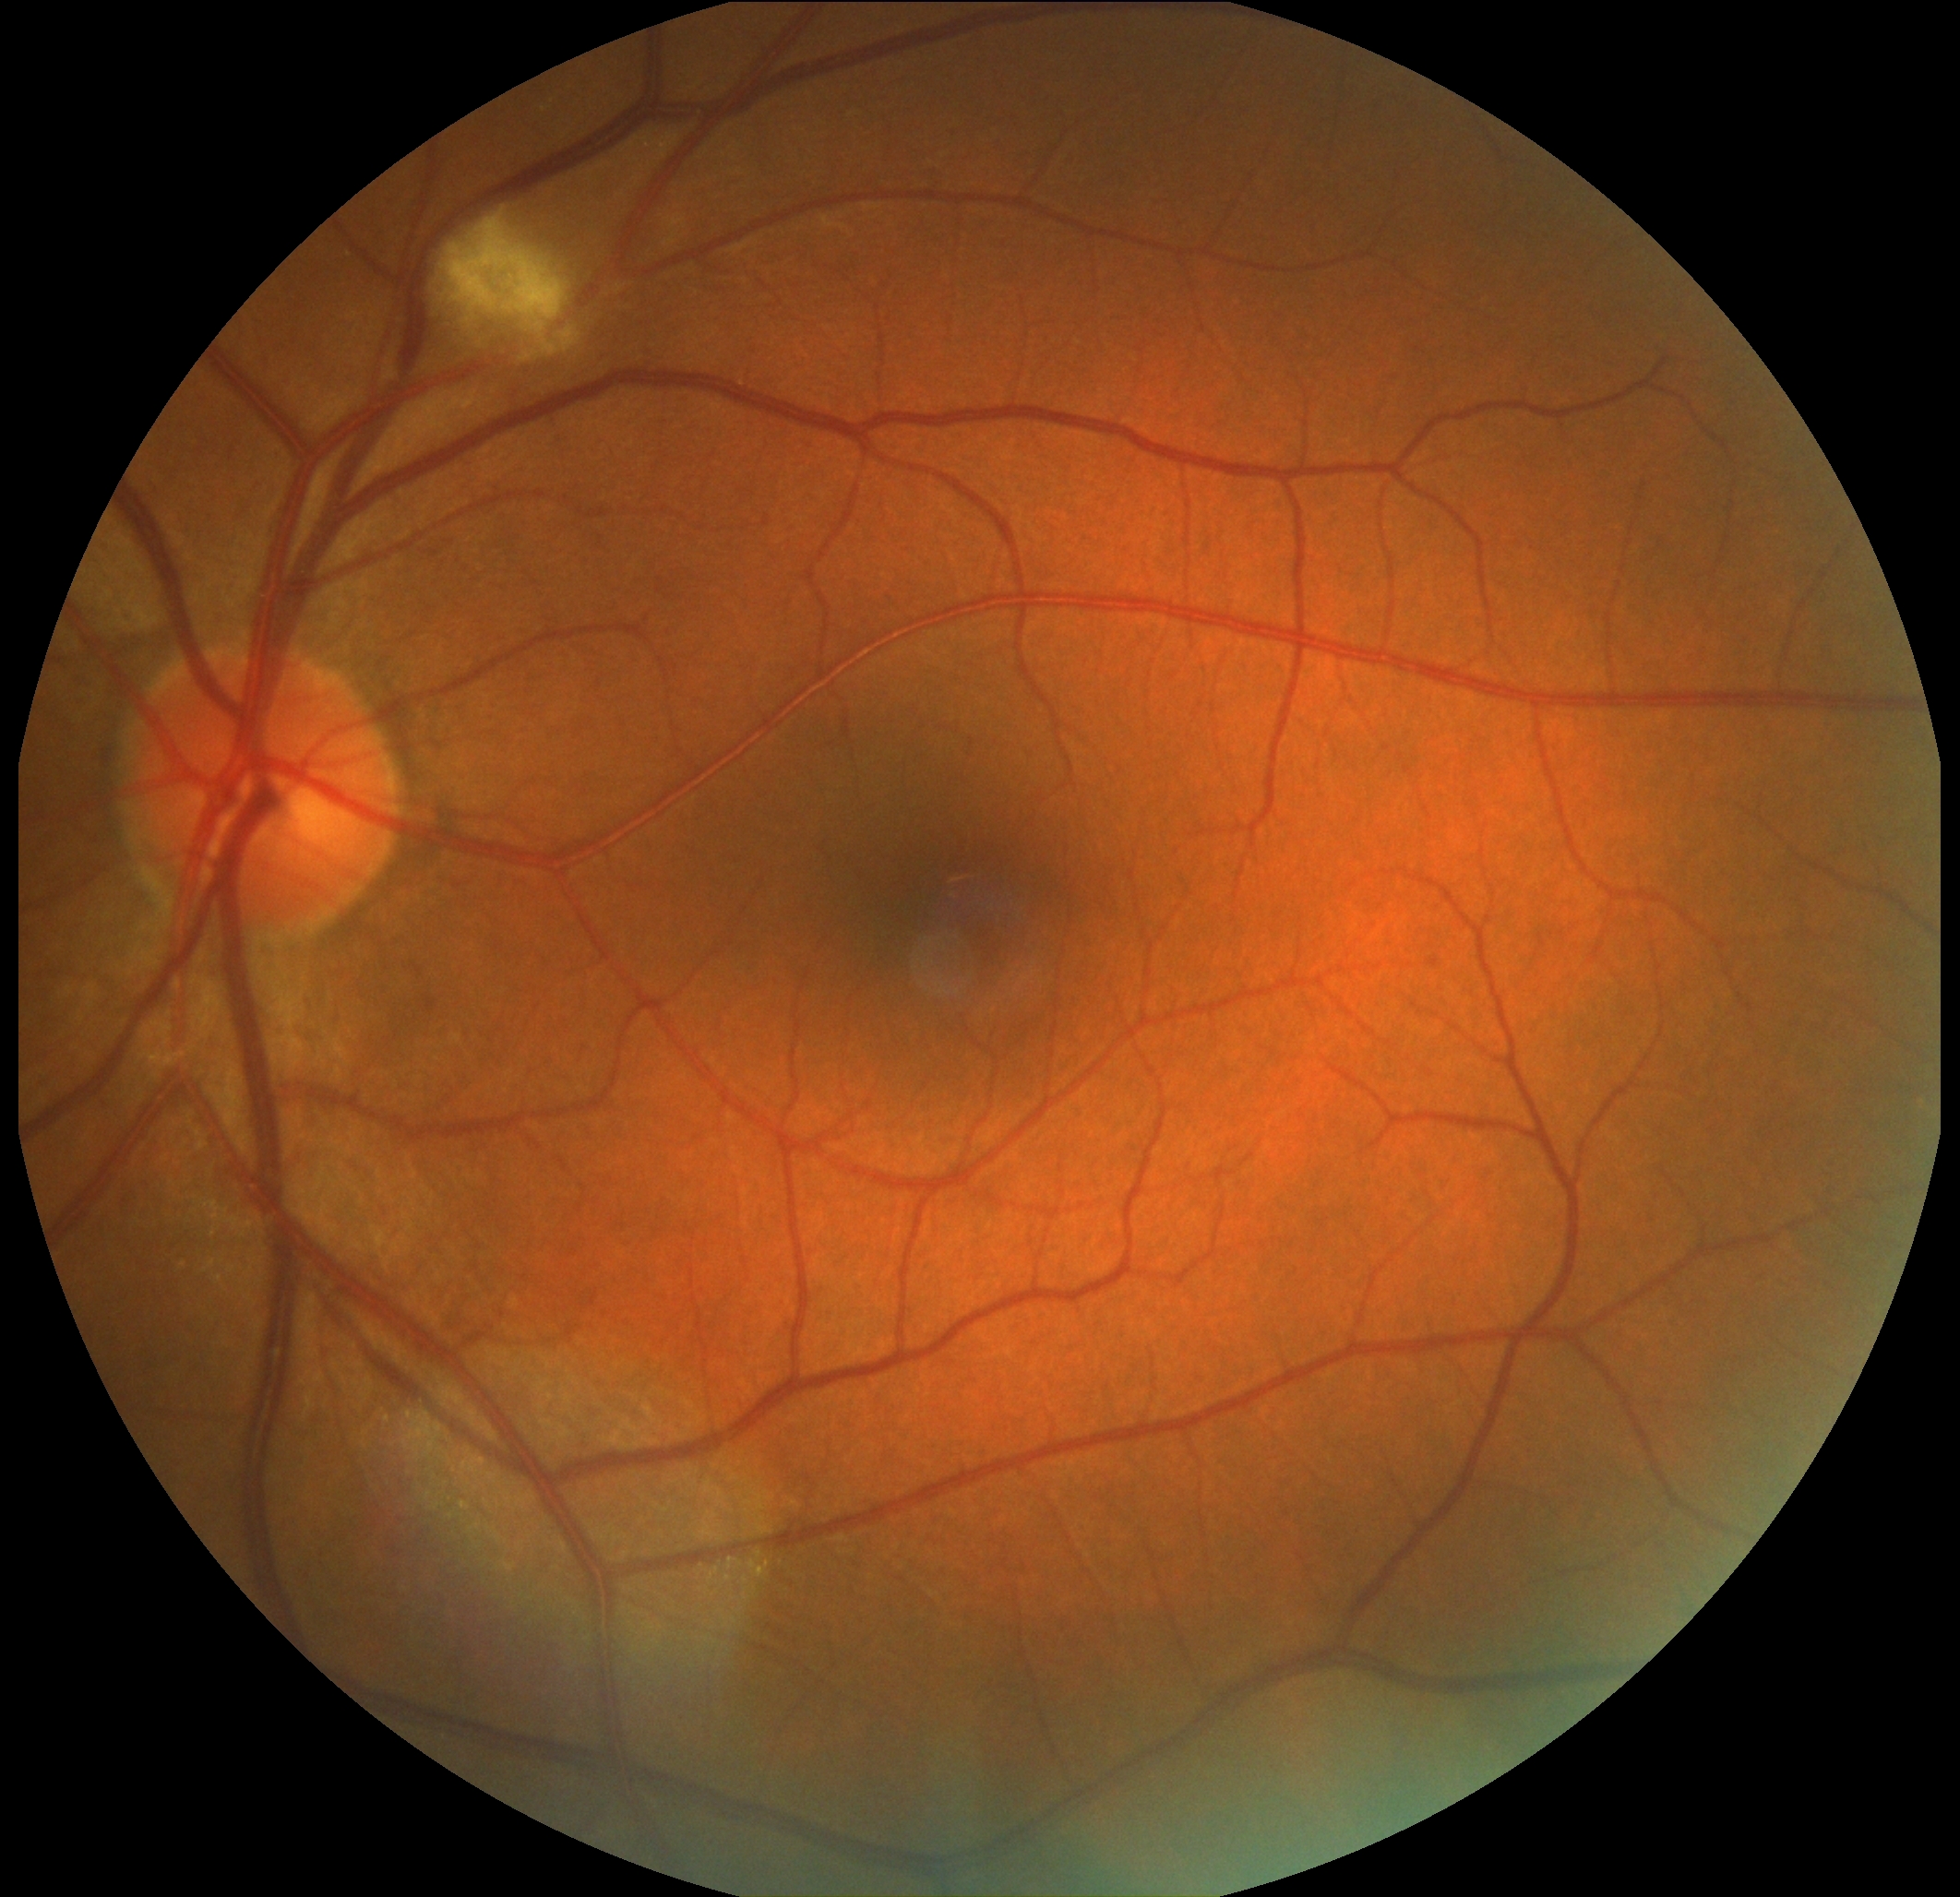 dr_grade: moderate NPDR (grade 2)